Captured with the Phoenix ICON (100° field of view). Infant wide-field retinal image.
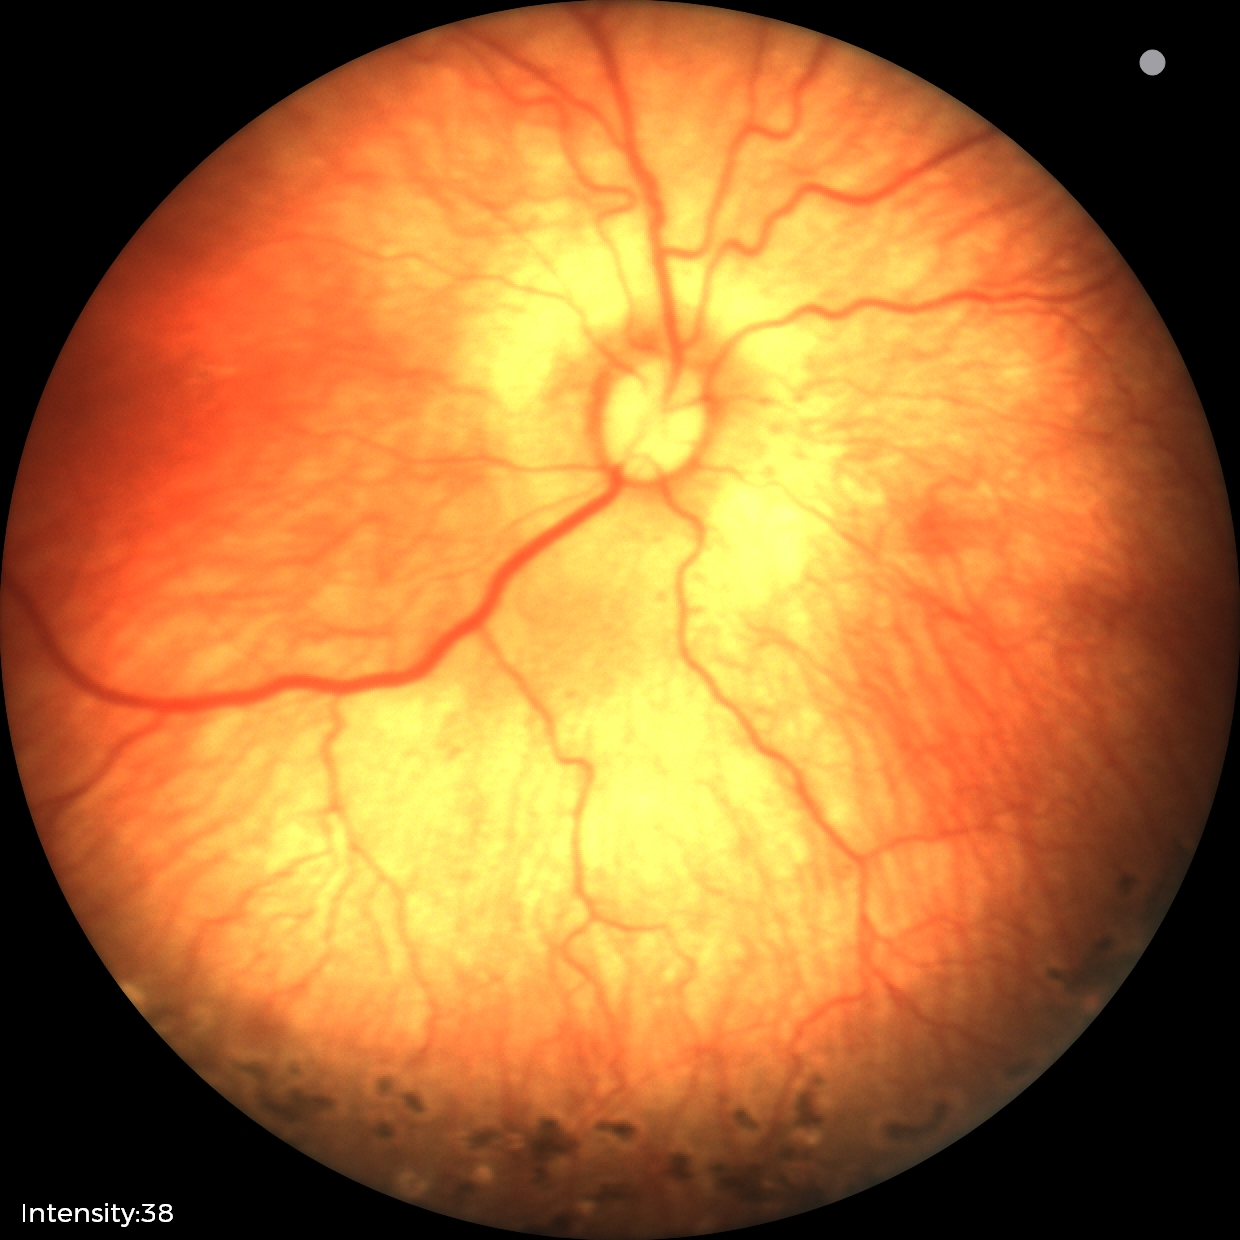
Screening examination consistent with status post retinopathy of prematurity.
Plus disease absent.